130° field of view (Clarity RetCam 3). Wide-field fundus photograph from neonatal ROP screening:
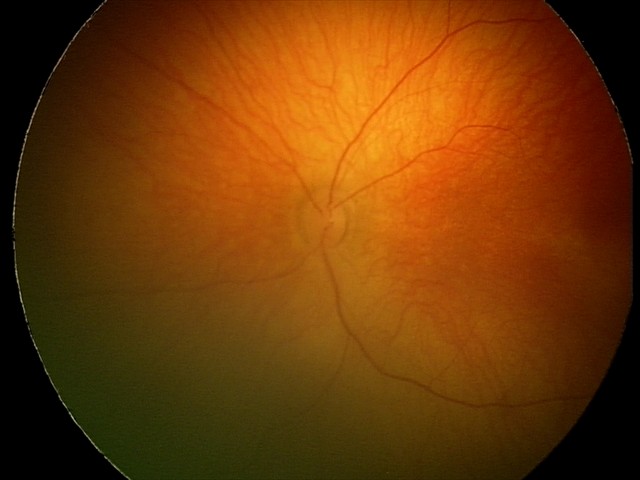
From an examination with diagnosis of retinal hemorrhages.